50° FOV — 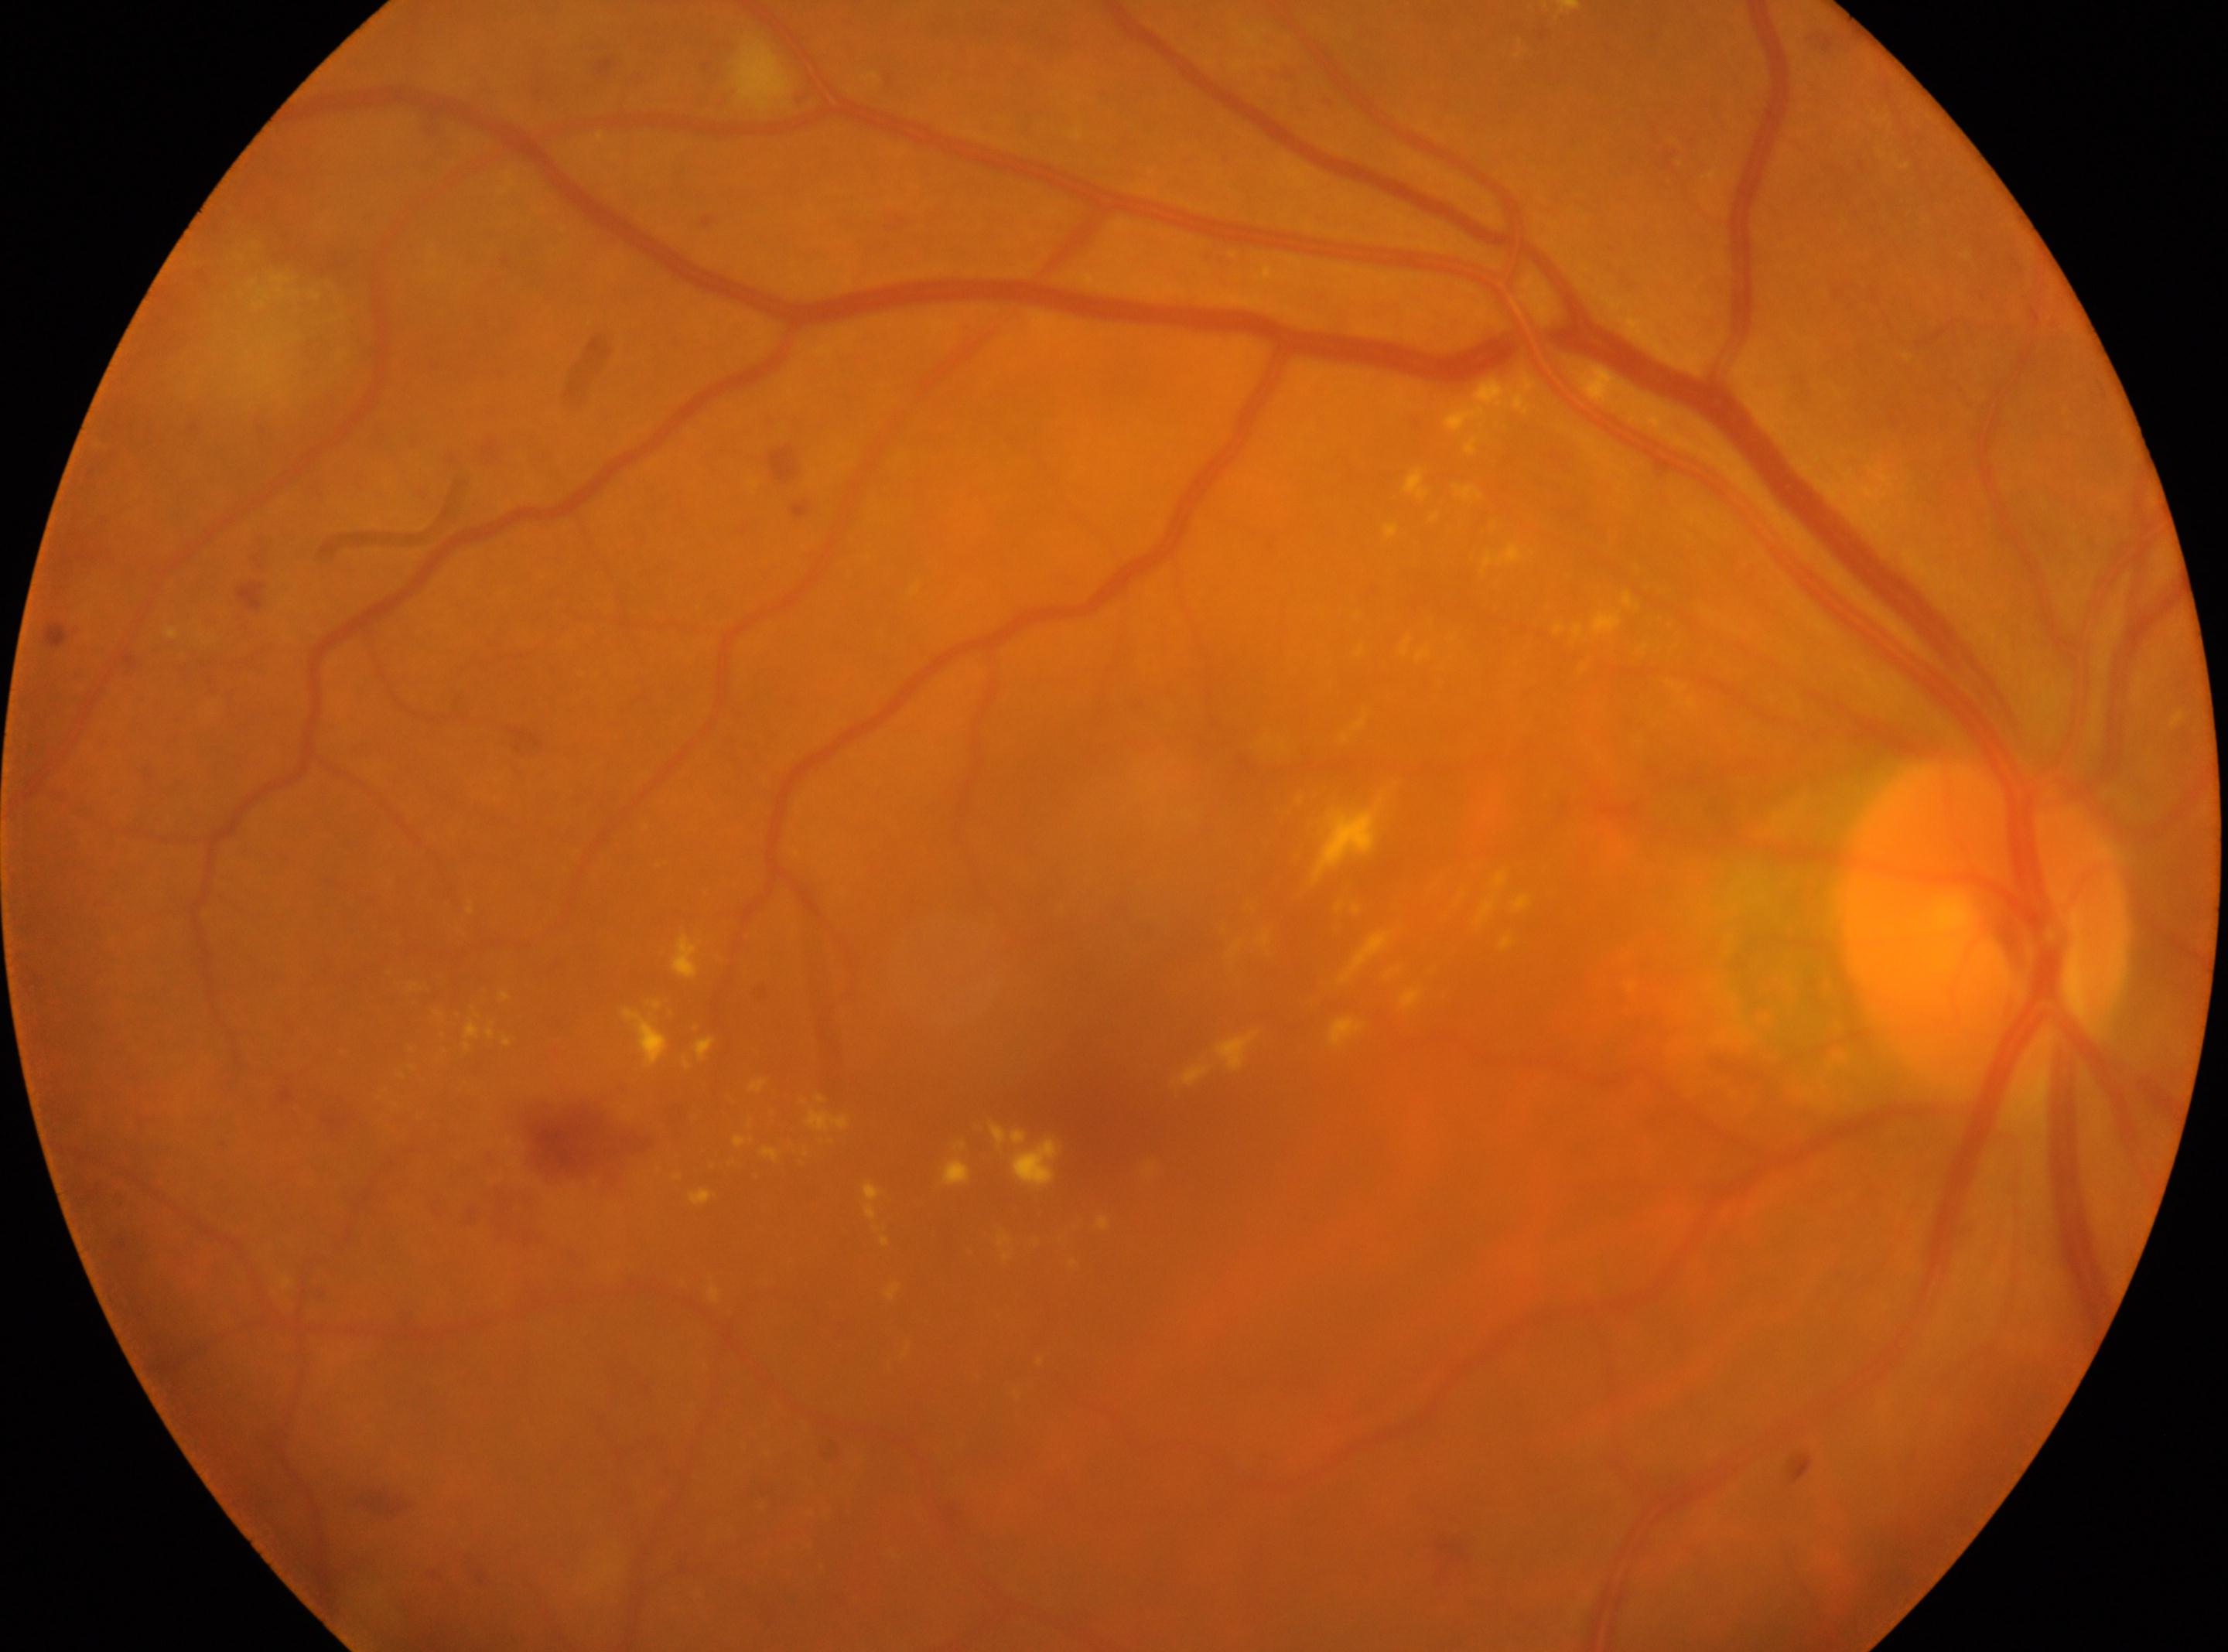

{"optic_disc": "1981, 928", "dr_grade": "moderate NPDR (grade 2)", "eye": "right eye", "fovea": "1099, 1081"}